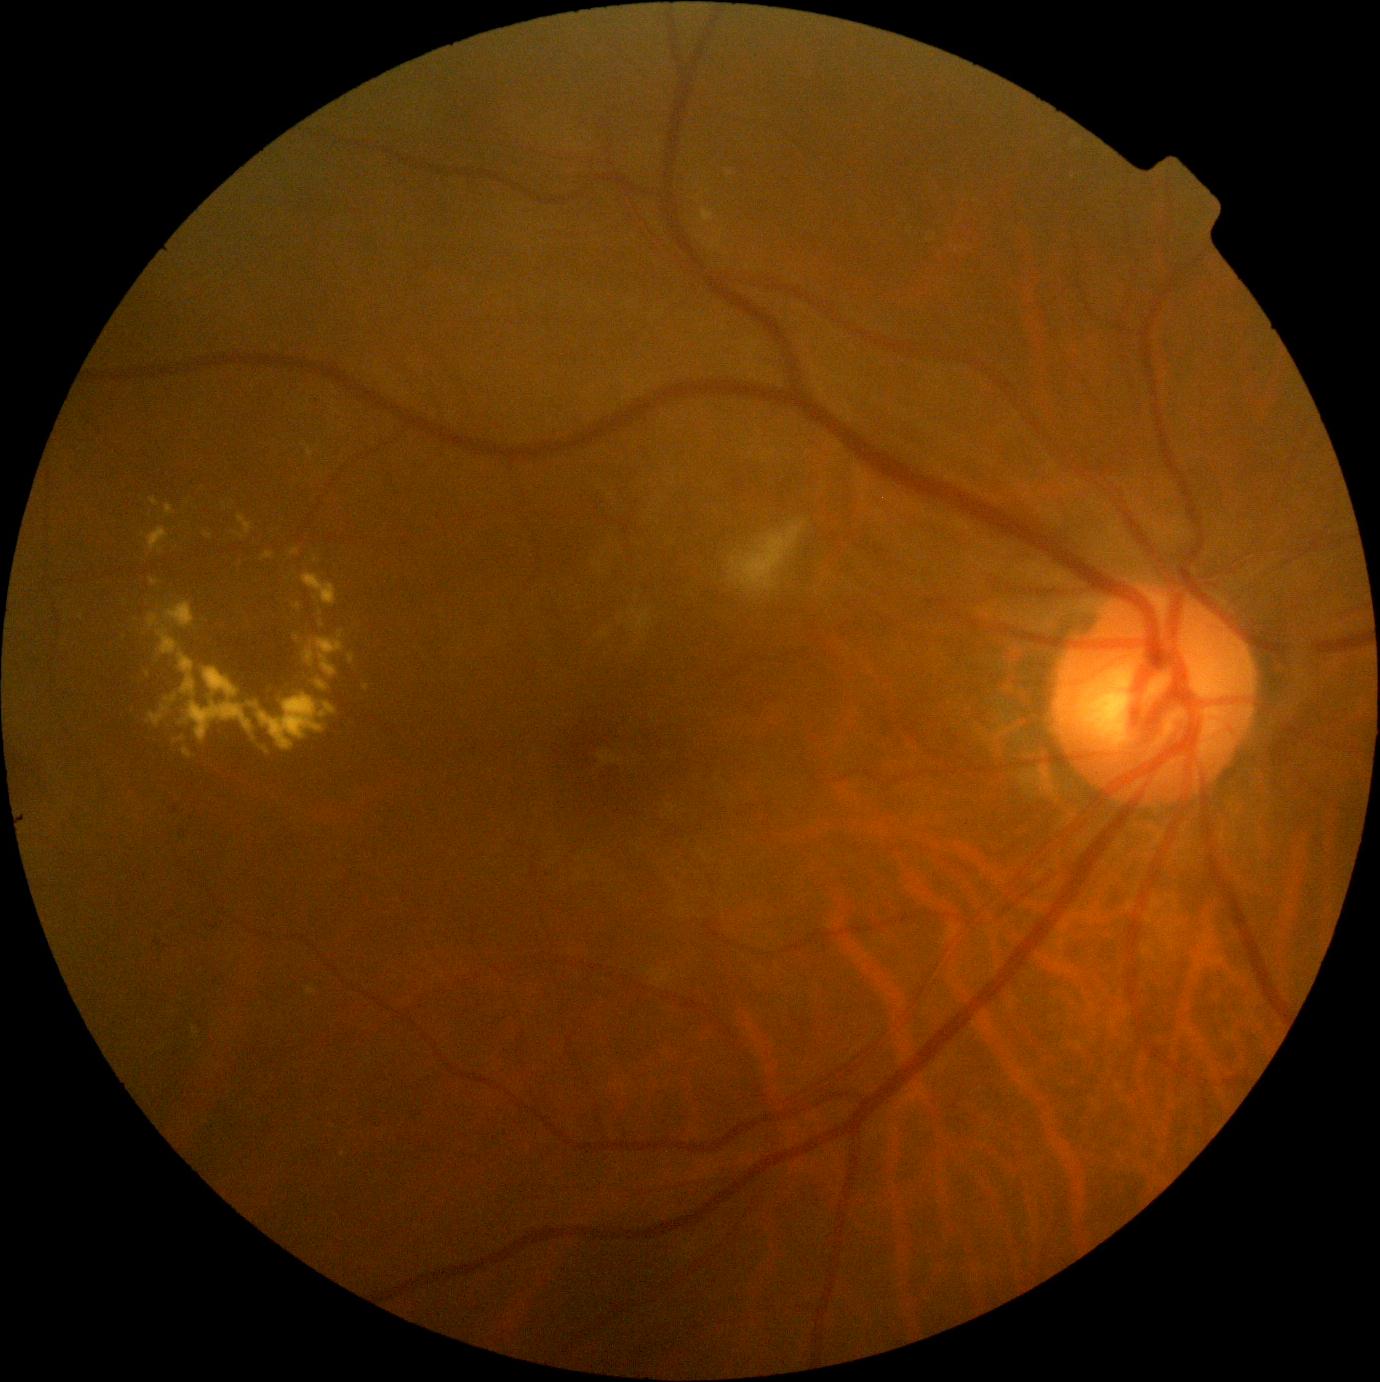

DR: moderate non-proliferative diabetic retinopathy (grade 2).